45-degree field of view; nonmydriatic fundus photograph; acquired with a NIDEK AFC-230
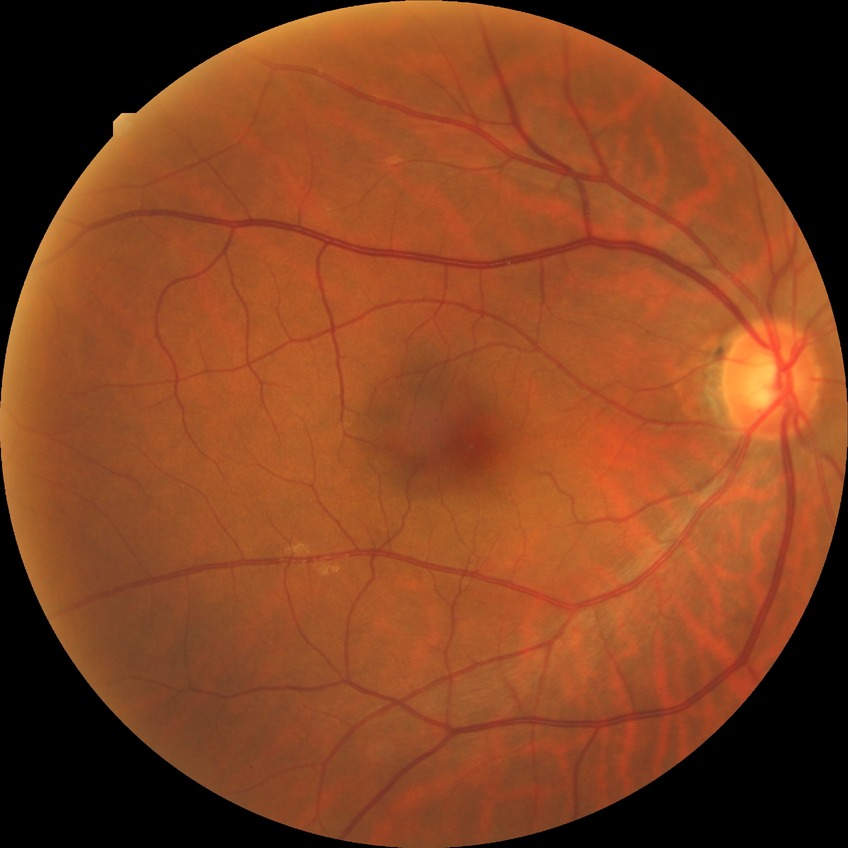 diabetic retinopathy stage = no diabetic retinopathy